640x480 · pediatric retinal photograph (wide-field).
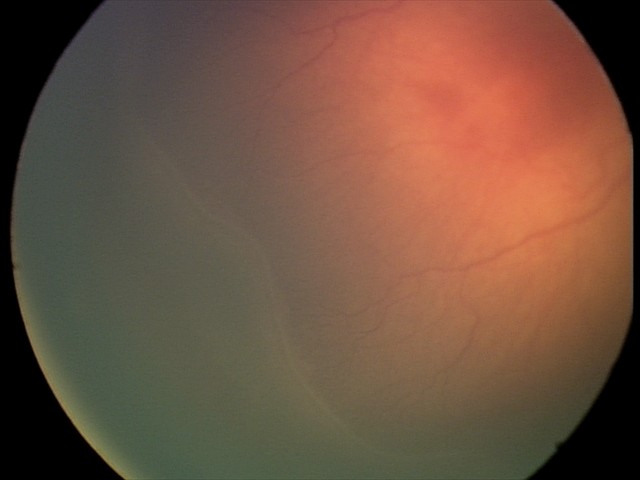

From an examination with diagnosis of retinopathy of prematurity (ROP) stage 2. Without plus disease.